848x848. Posterior pole color fundus photograph. NIDEK AFC-230.
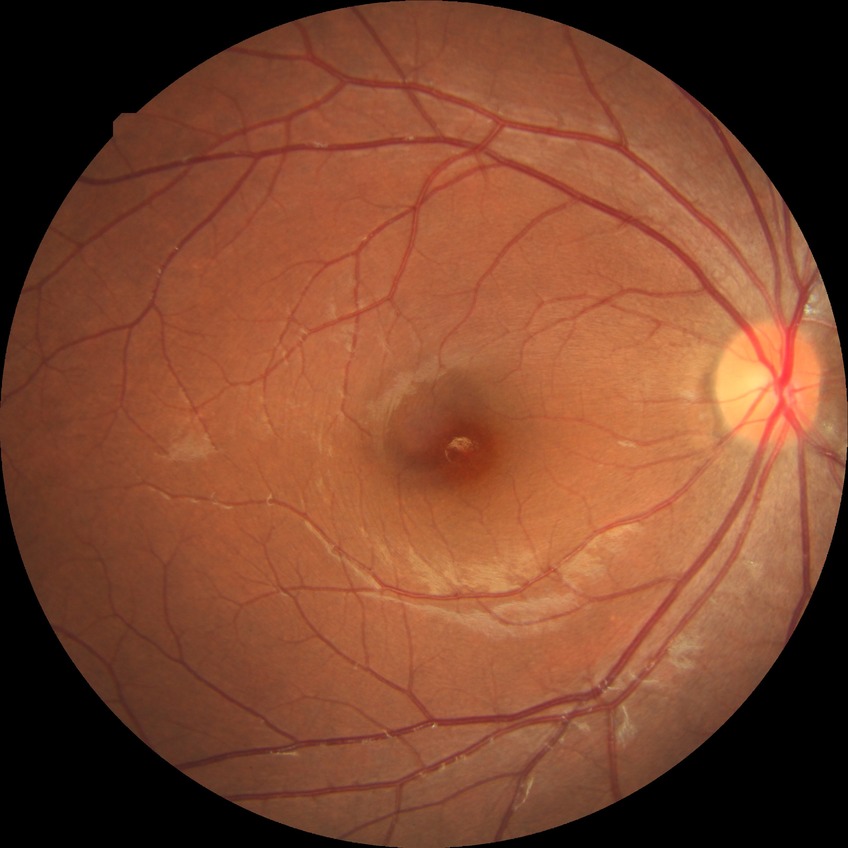 Davis grade: NDR.